CFP; 45° FOV:
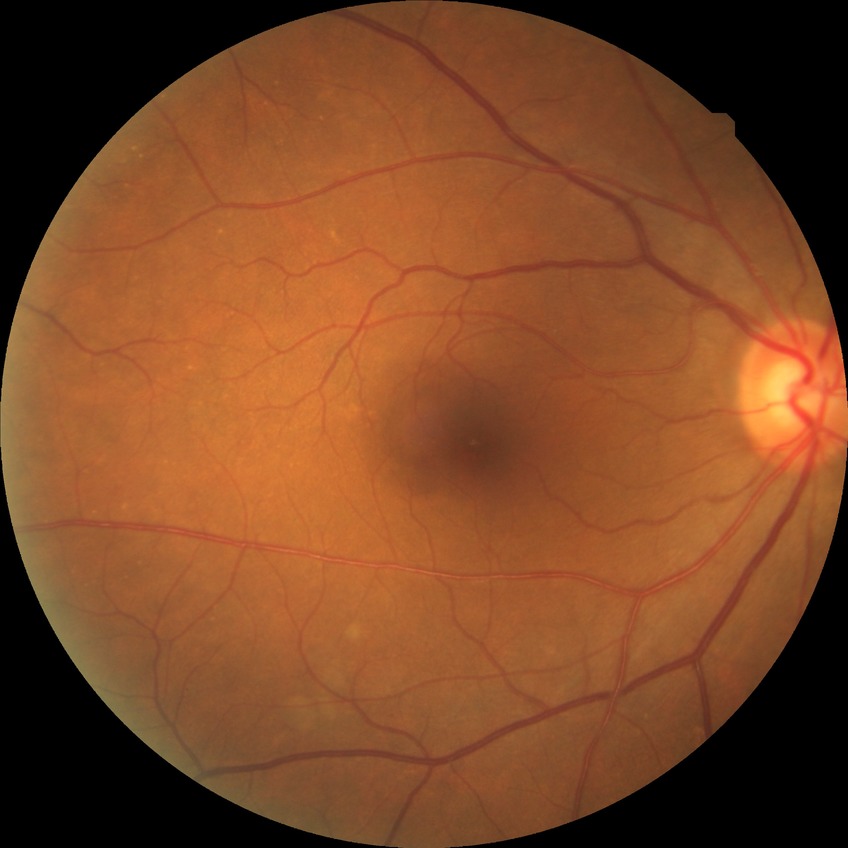

Modified Davis grading: no diabetic retinopathy.